Graded on the modified Davis scale. 45° field of view:
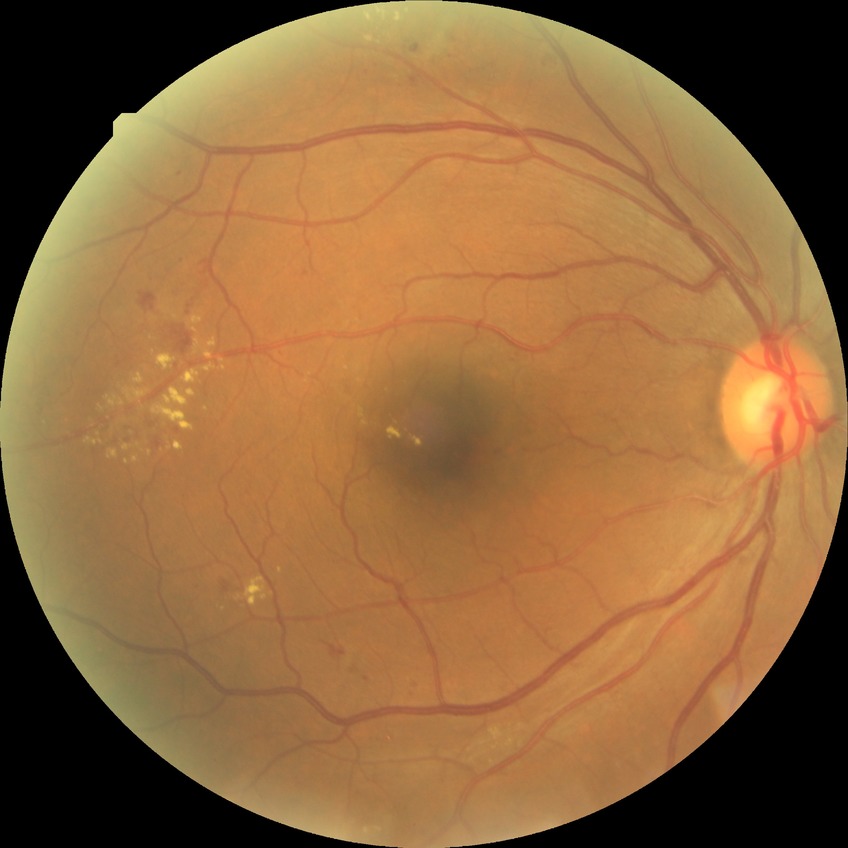 DR: SDR.